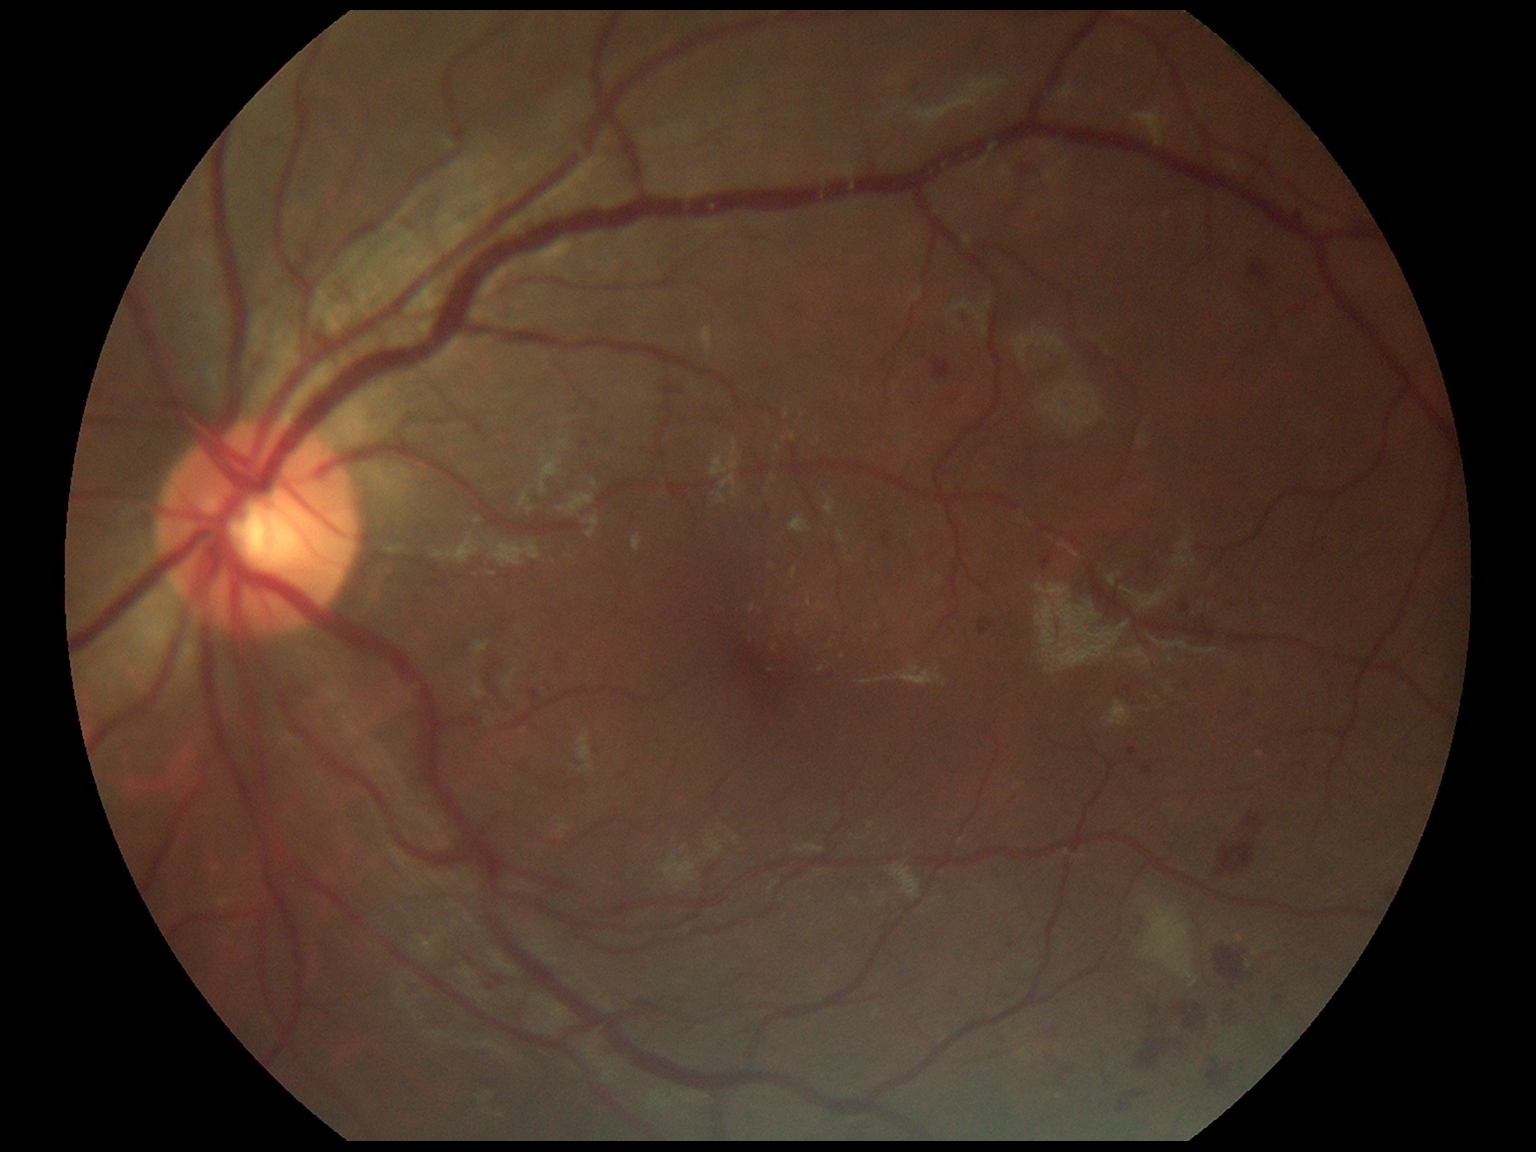 Diabetic retinopathy severity is grade 2 — more than just microaneurysms but less than severe NPDR.